Retinal fundus photograph · 1659x2212
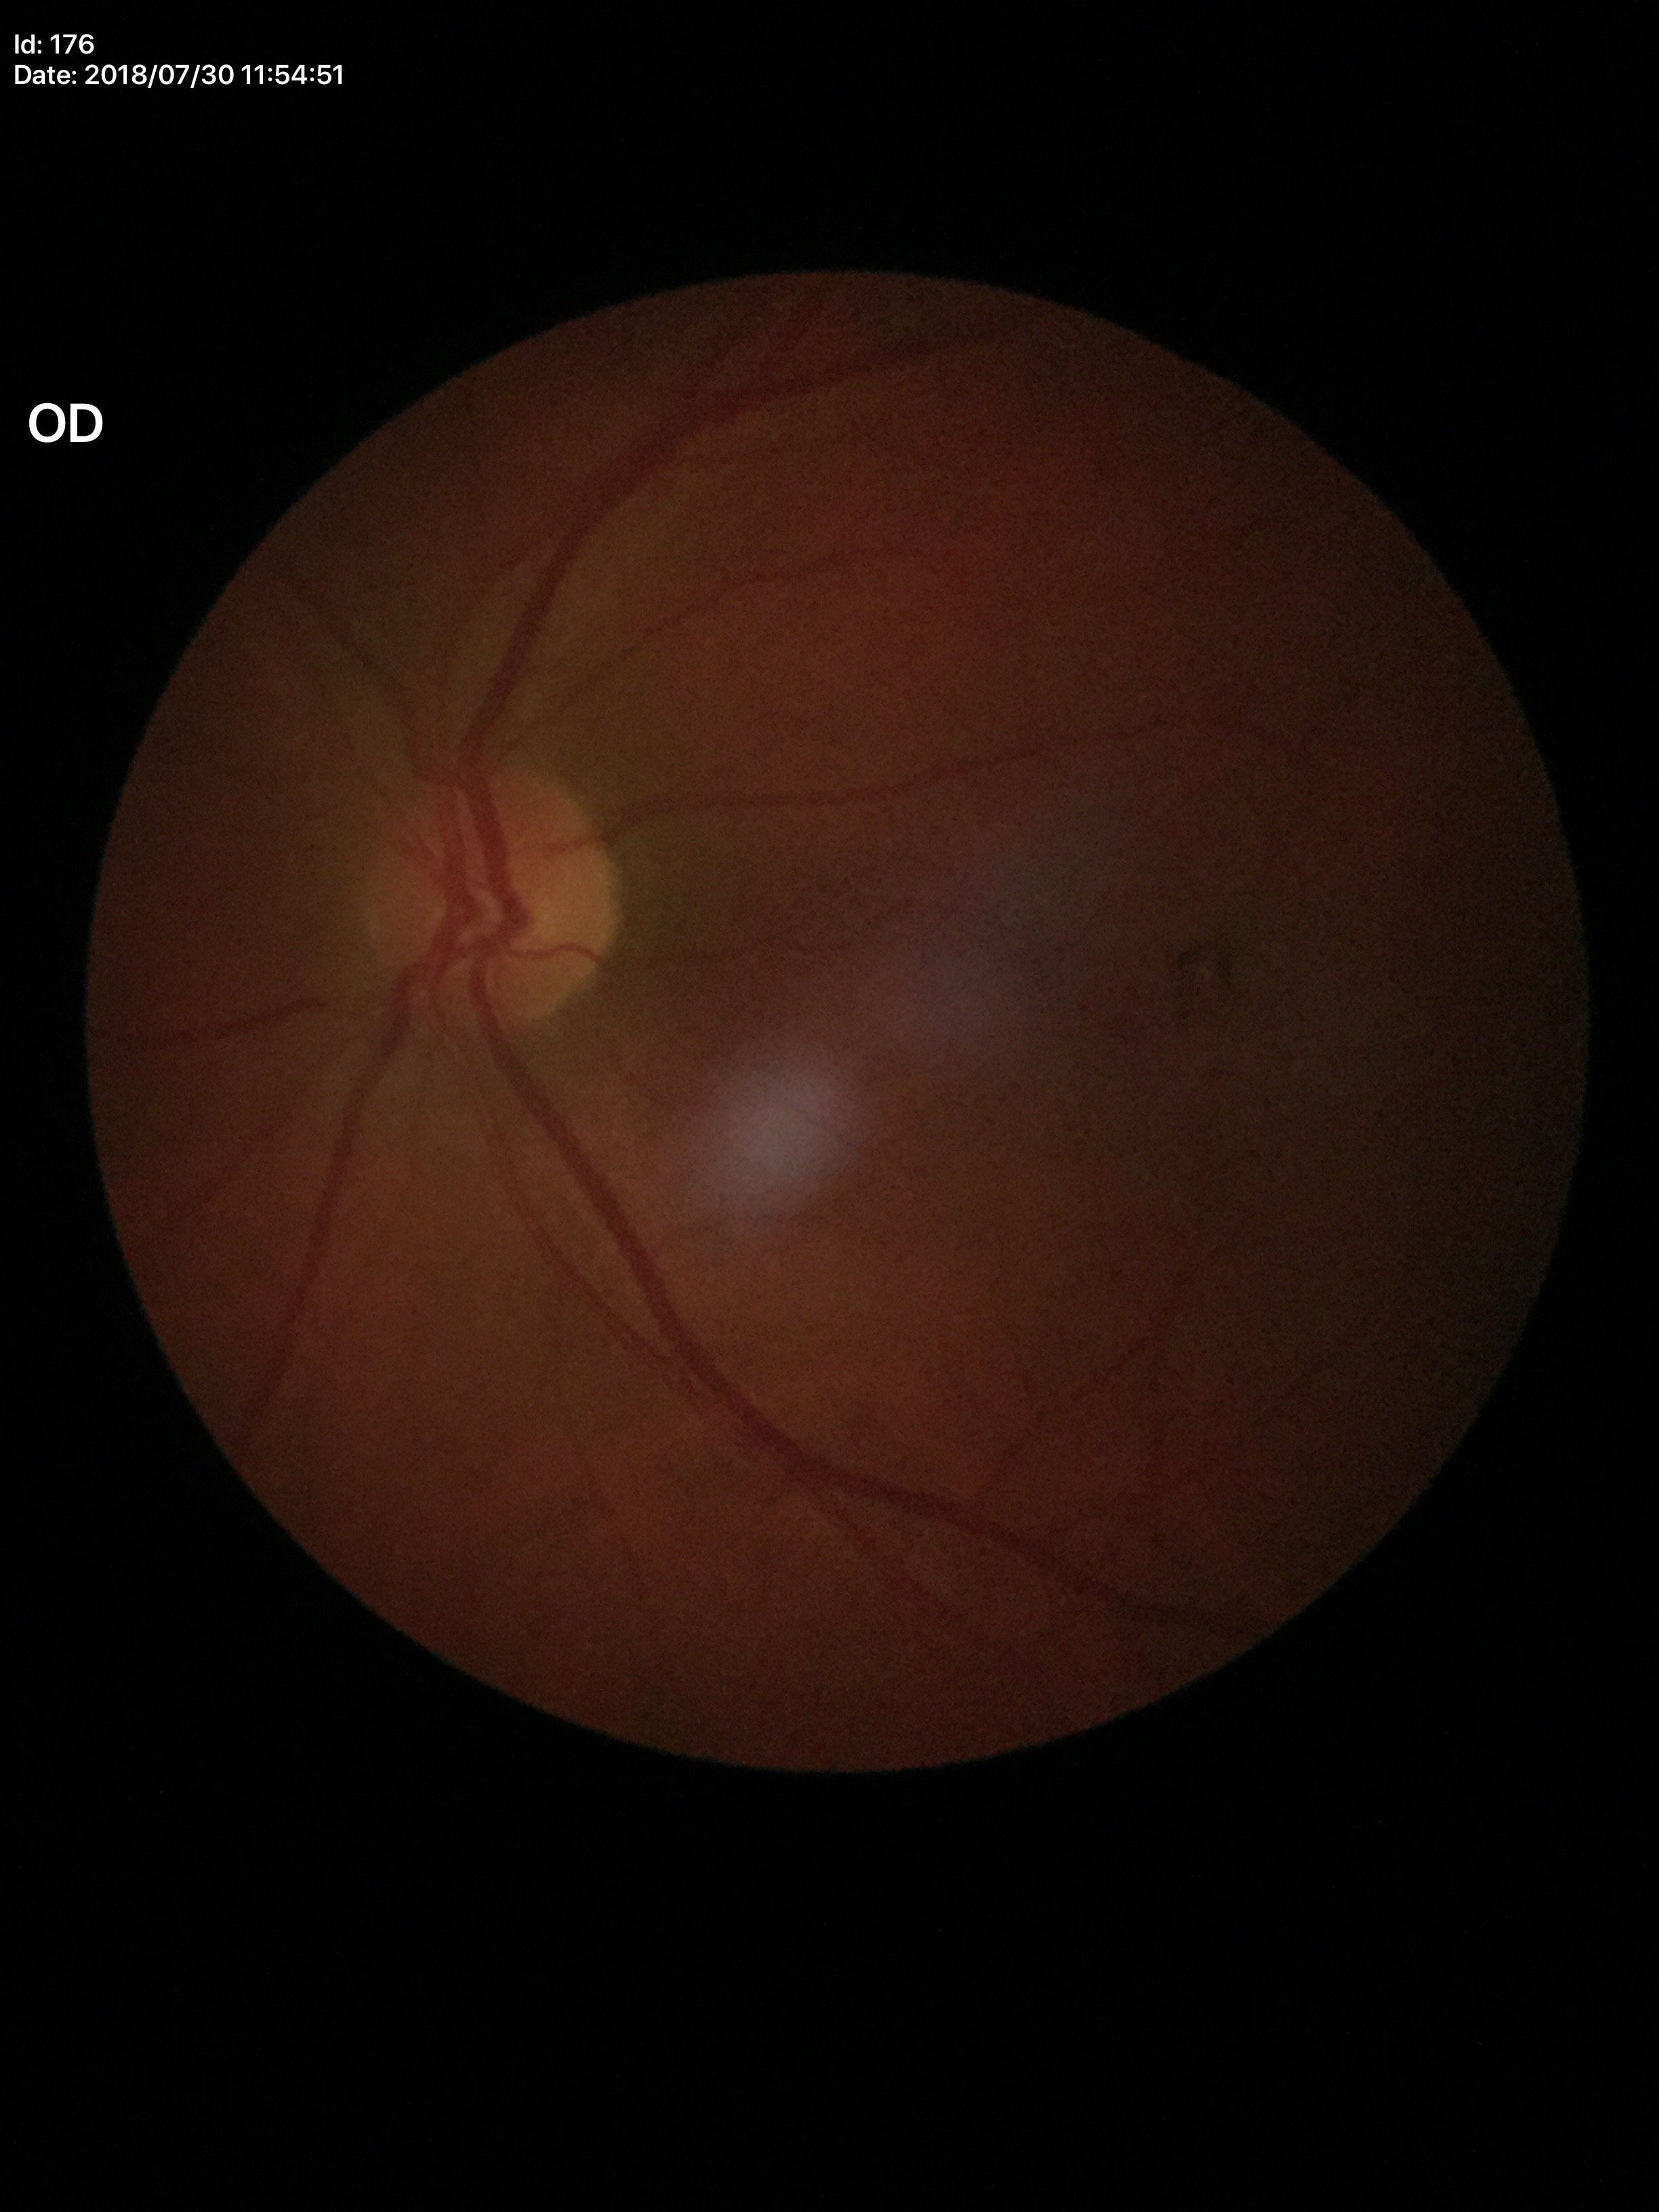
Vertical cup-to-disc ratio (VCDR) is 0.47. Horizontal C/D ratio (HCDR): 0.48. Glaucoma evaluation: negative.